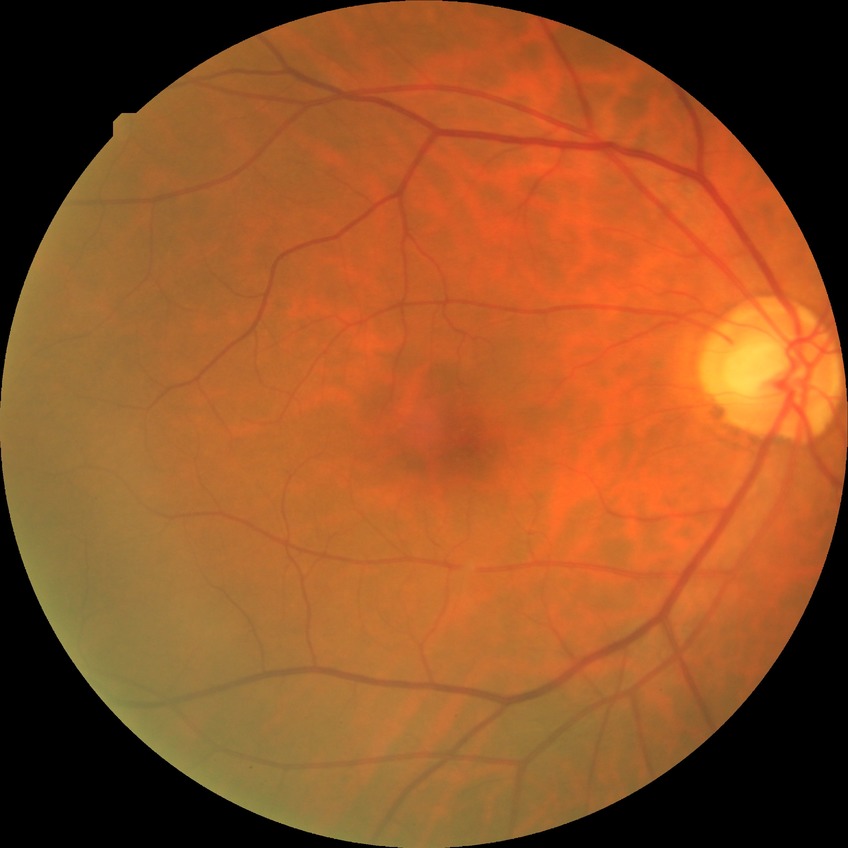

diabetic retinopathy (DR): no diabetic retinopathy (NDR).